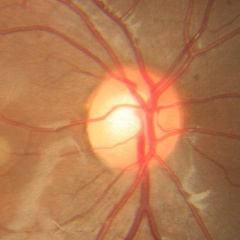 No signs of glaucoma.